2212 by 1659 pixels · 45° field of view: 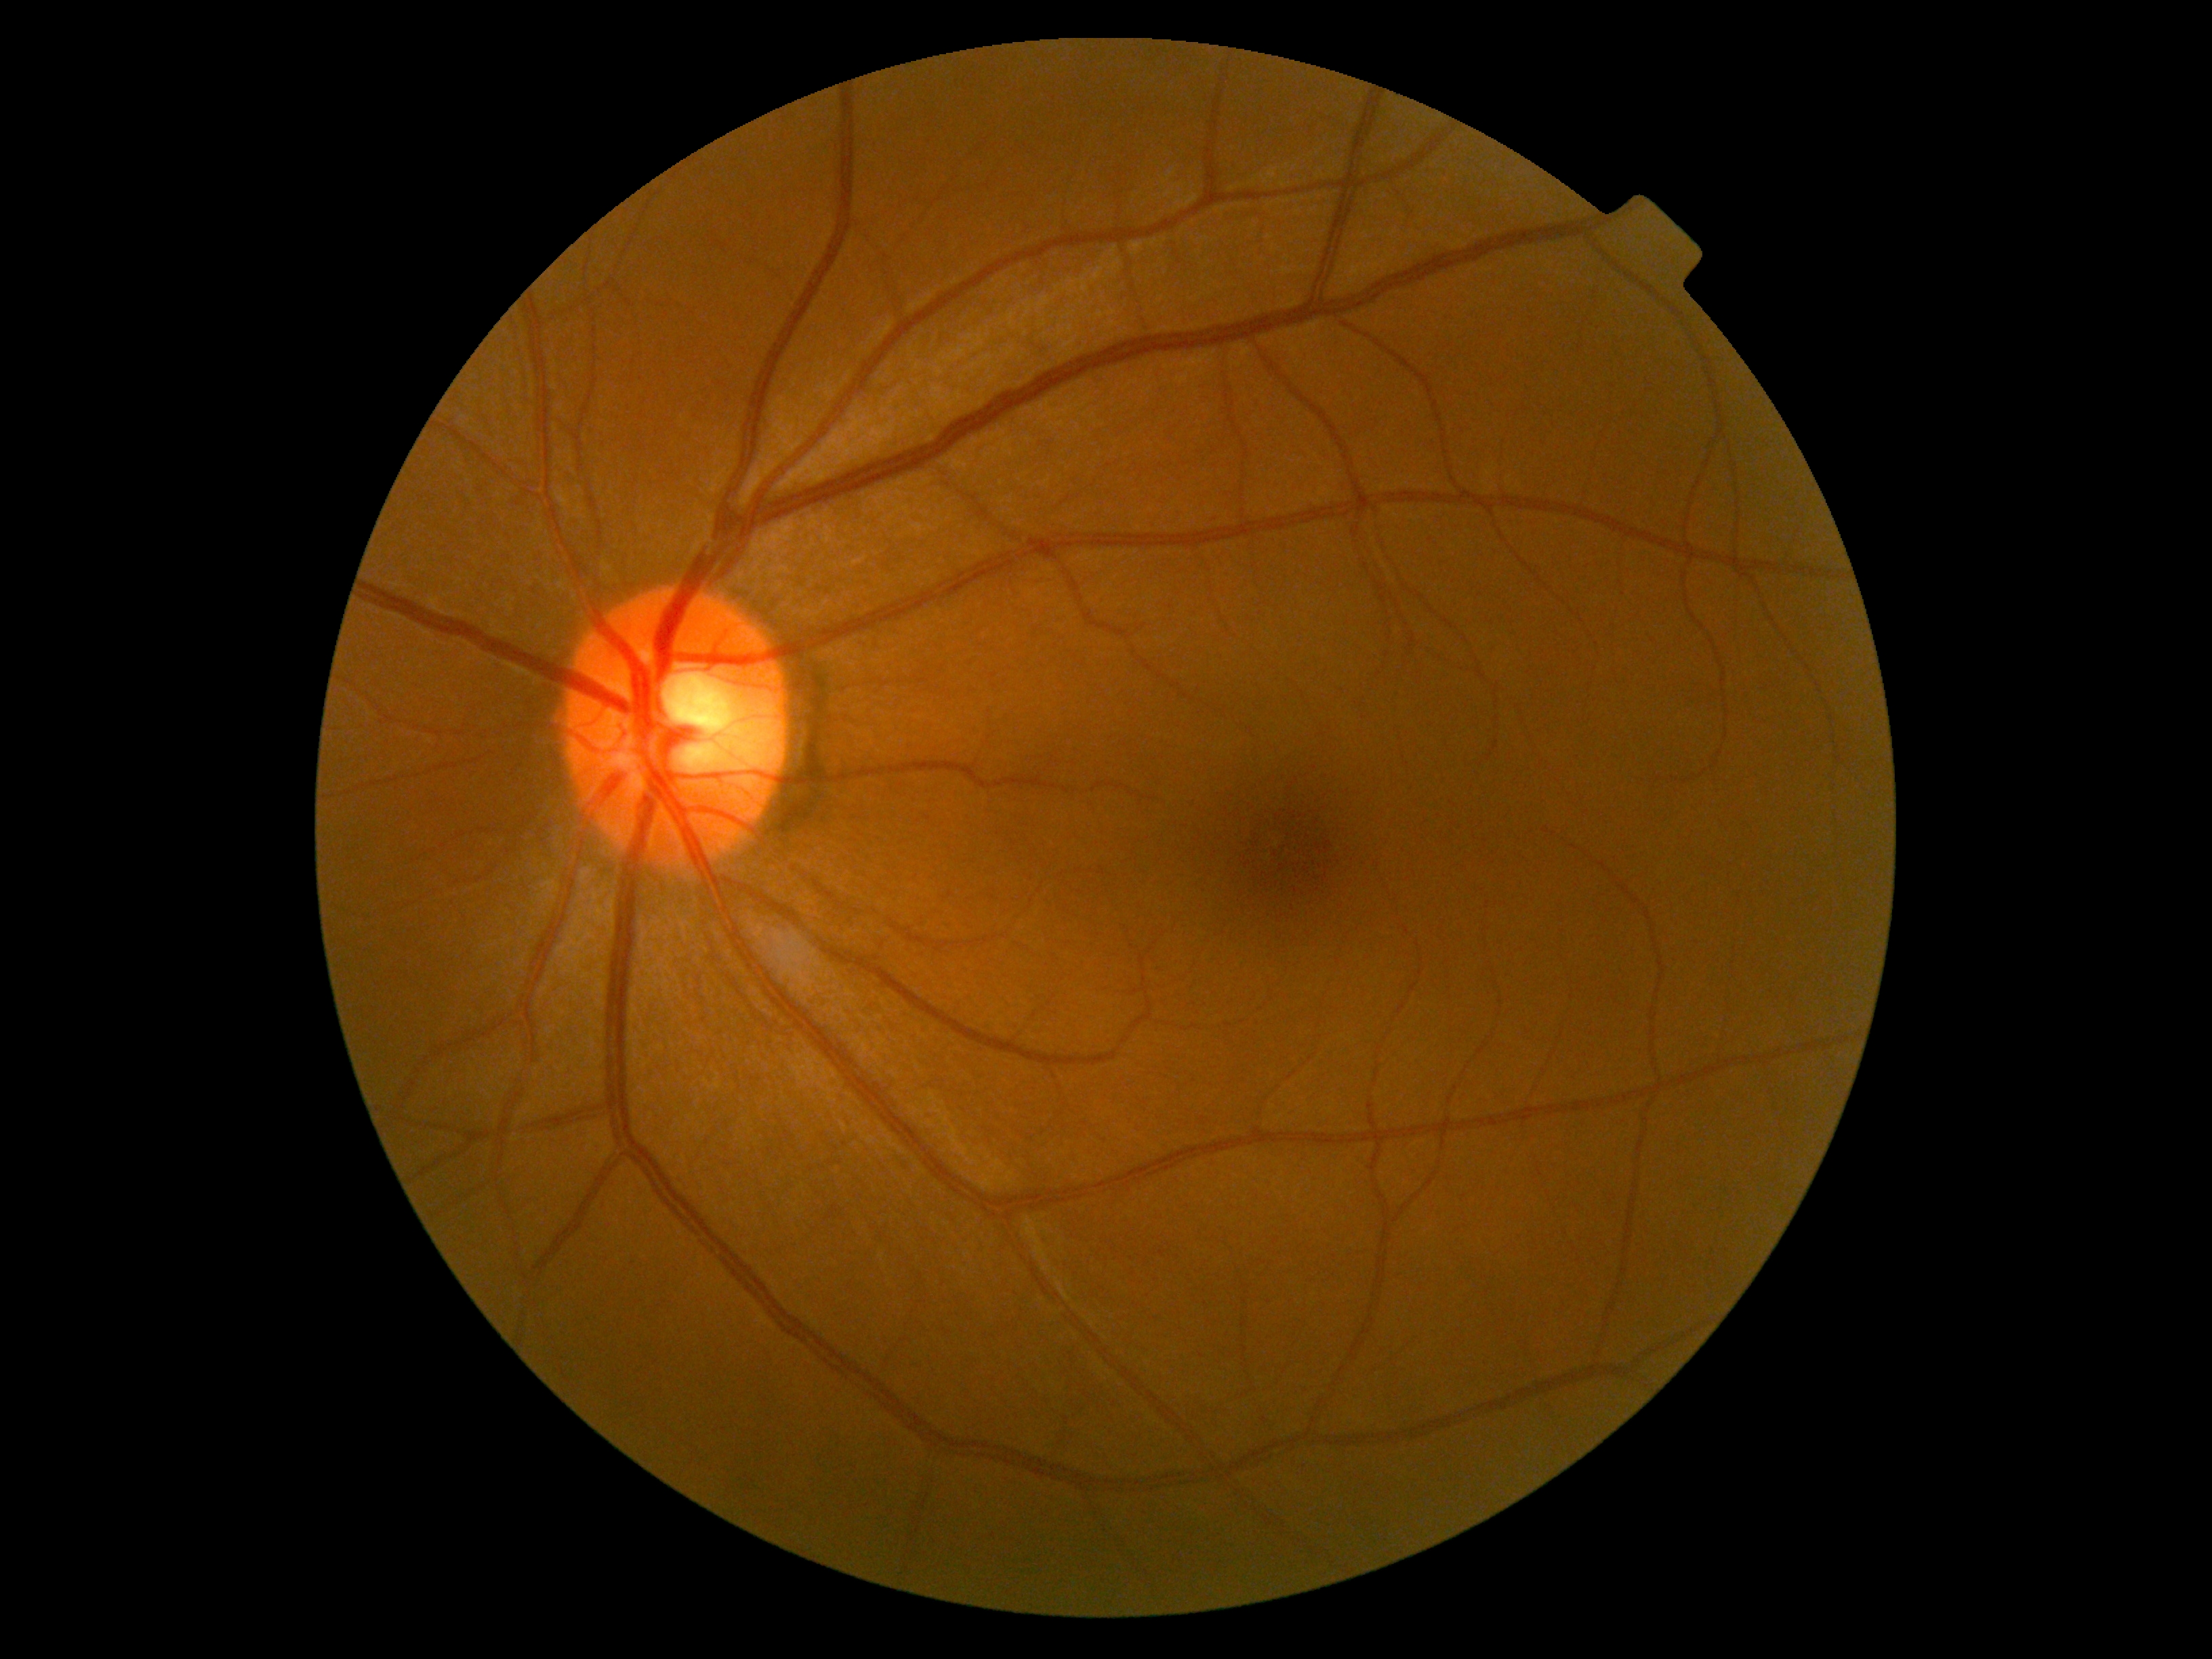 DR: grade 0.